Mydriatic (tropicamide and phenylephrine), field includes the optic disc and macula, captured on a Topcon TRC-50DX fundus camera, 2228 x 1652 pixels
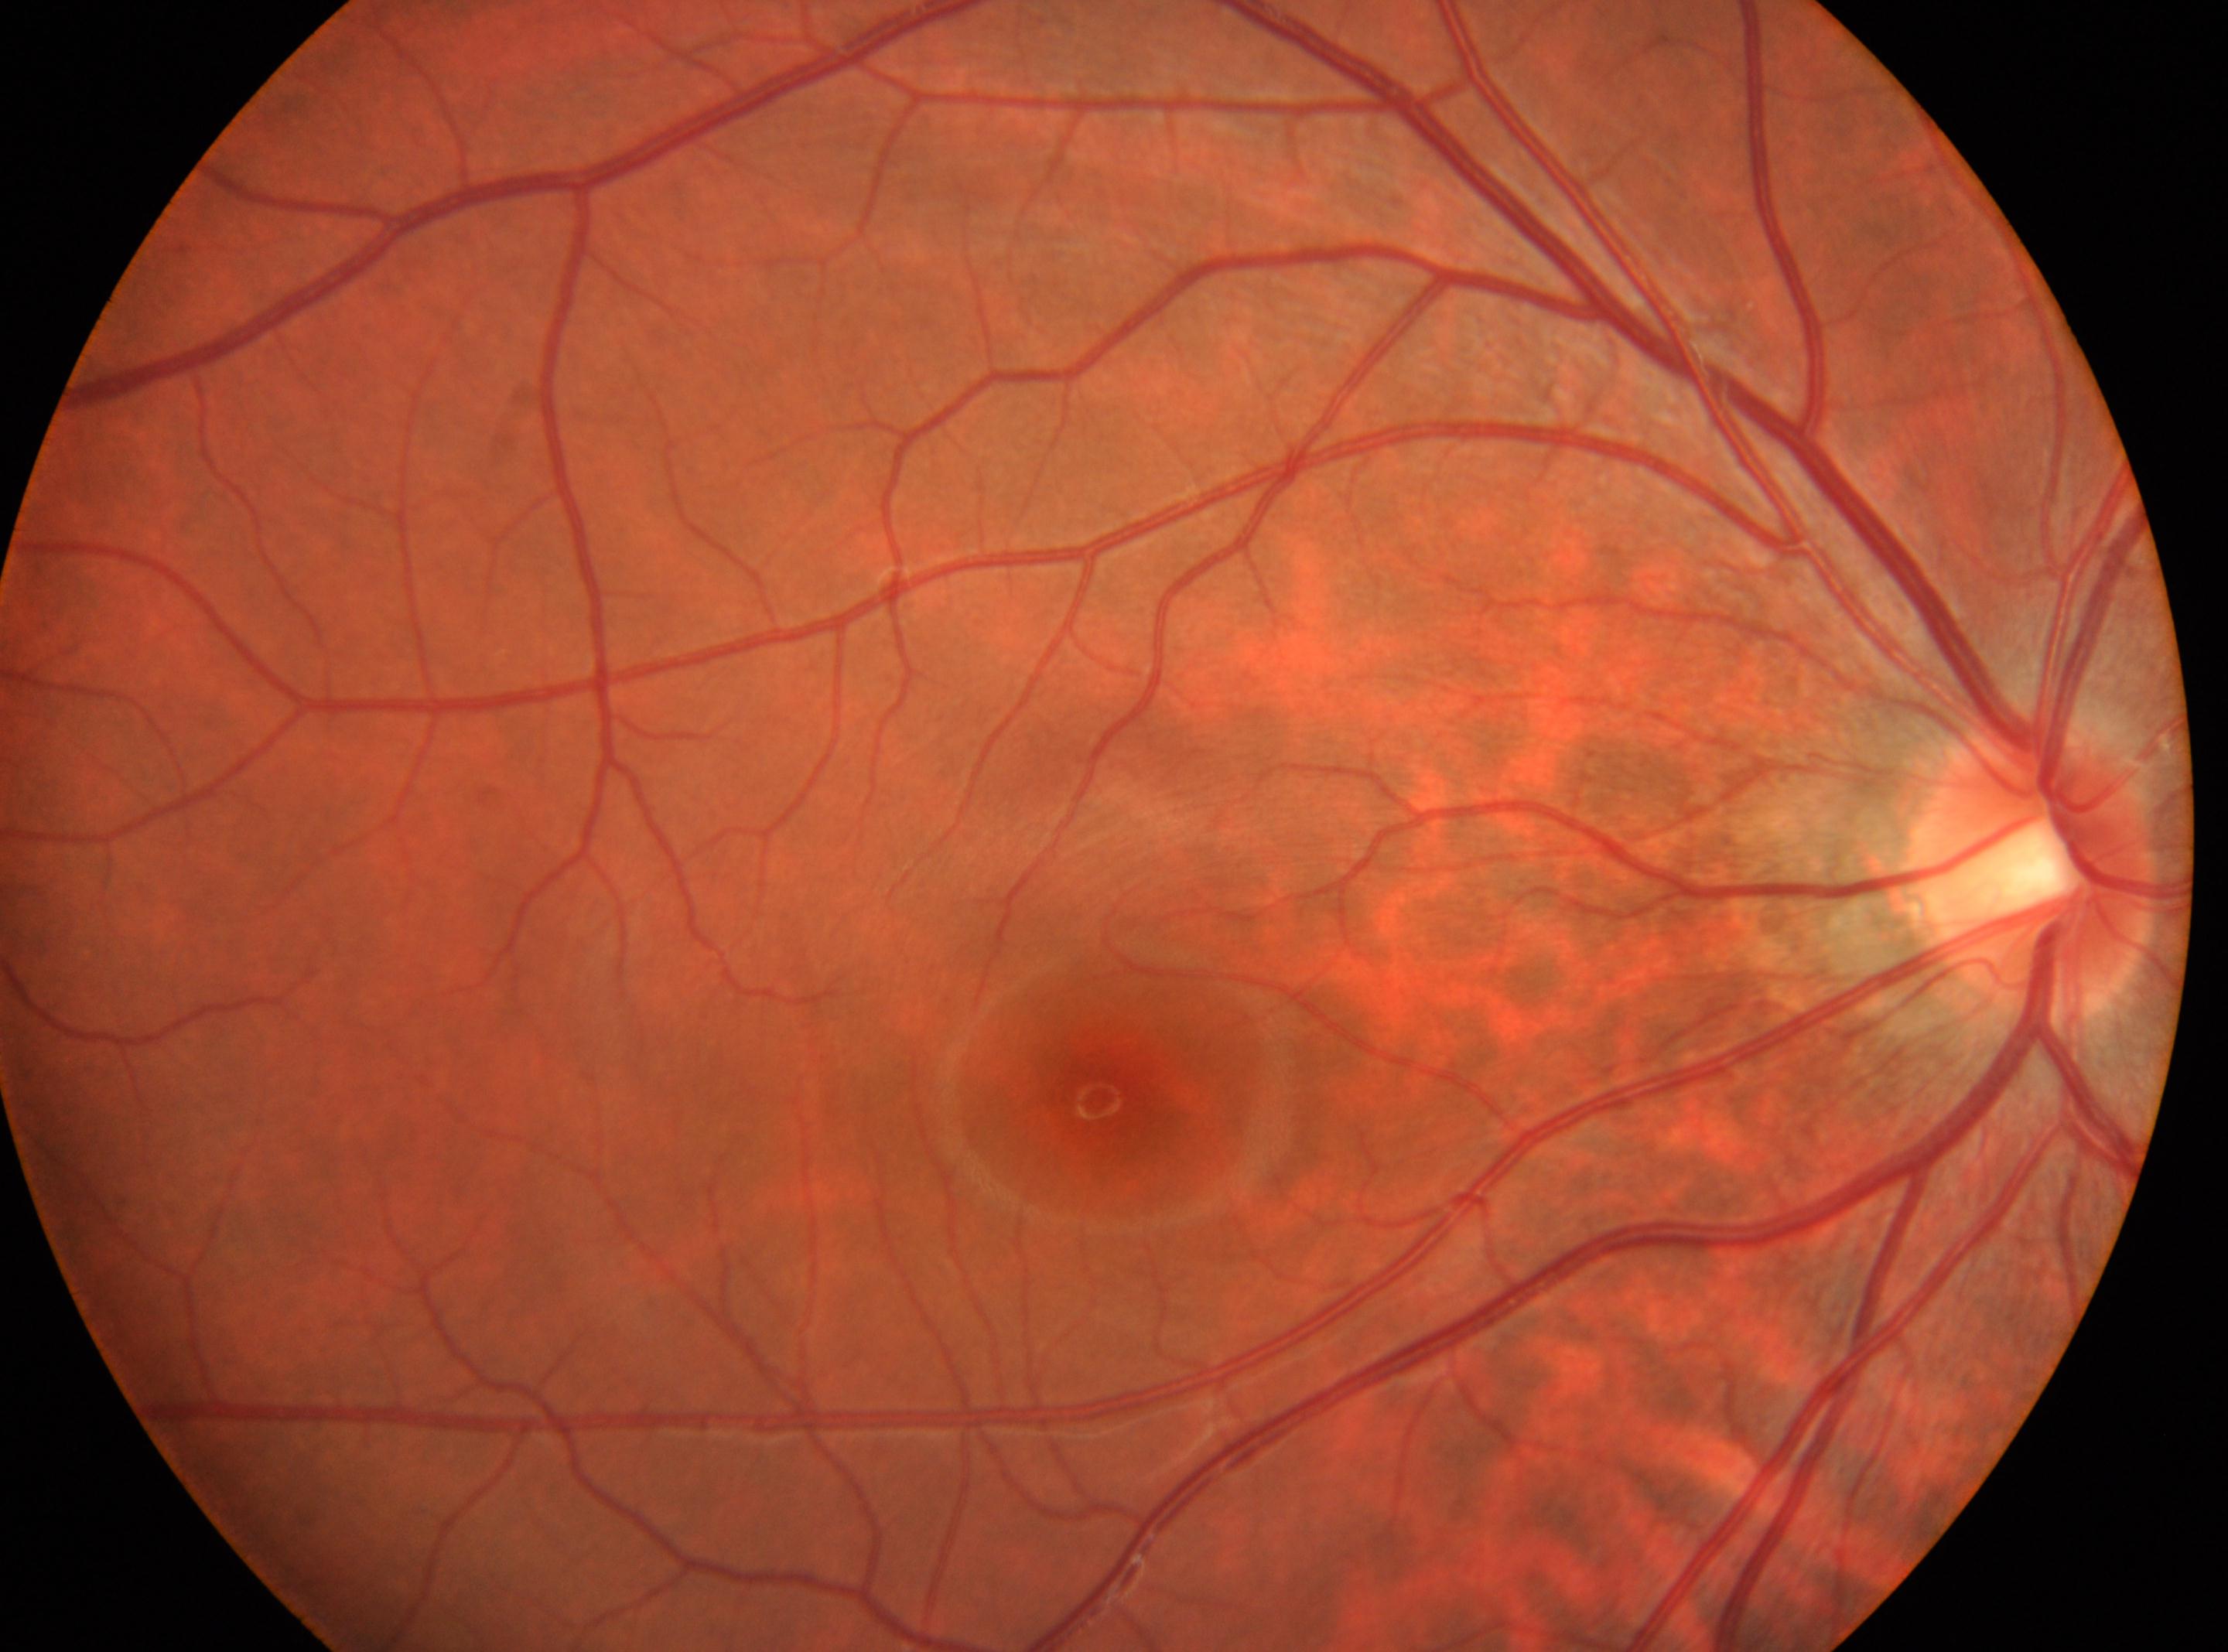
ONH: x=2030, y=868
laterality: the right eye
retinopathy: grade 0 (no apparent retinopathy) — no visible signs of diabetic retinopathy
macula center: x=1097, y=1101